No pharmacologic dilation:
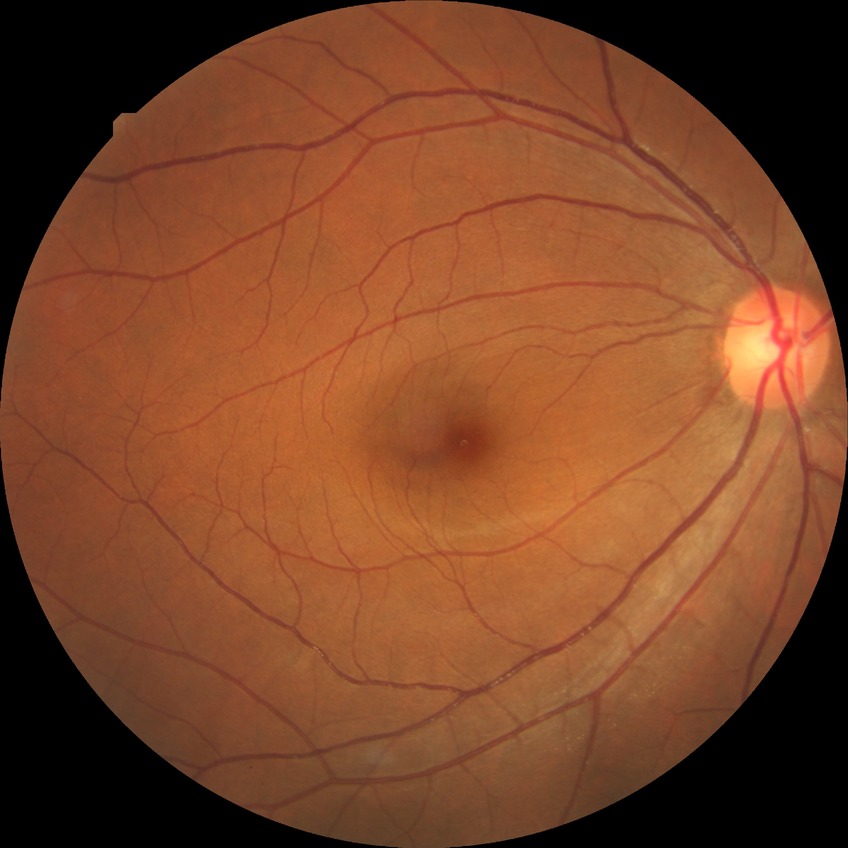 Findings:
* Davis grading — no diabetic retinopathy